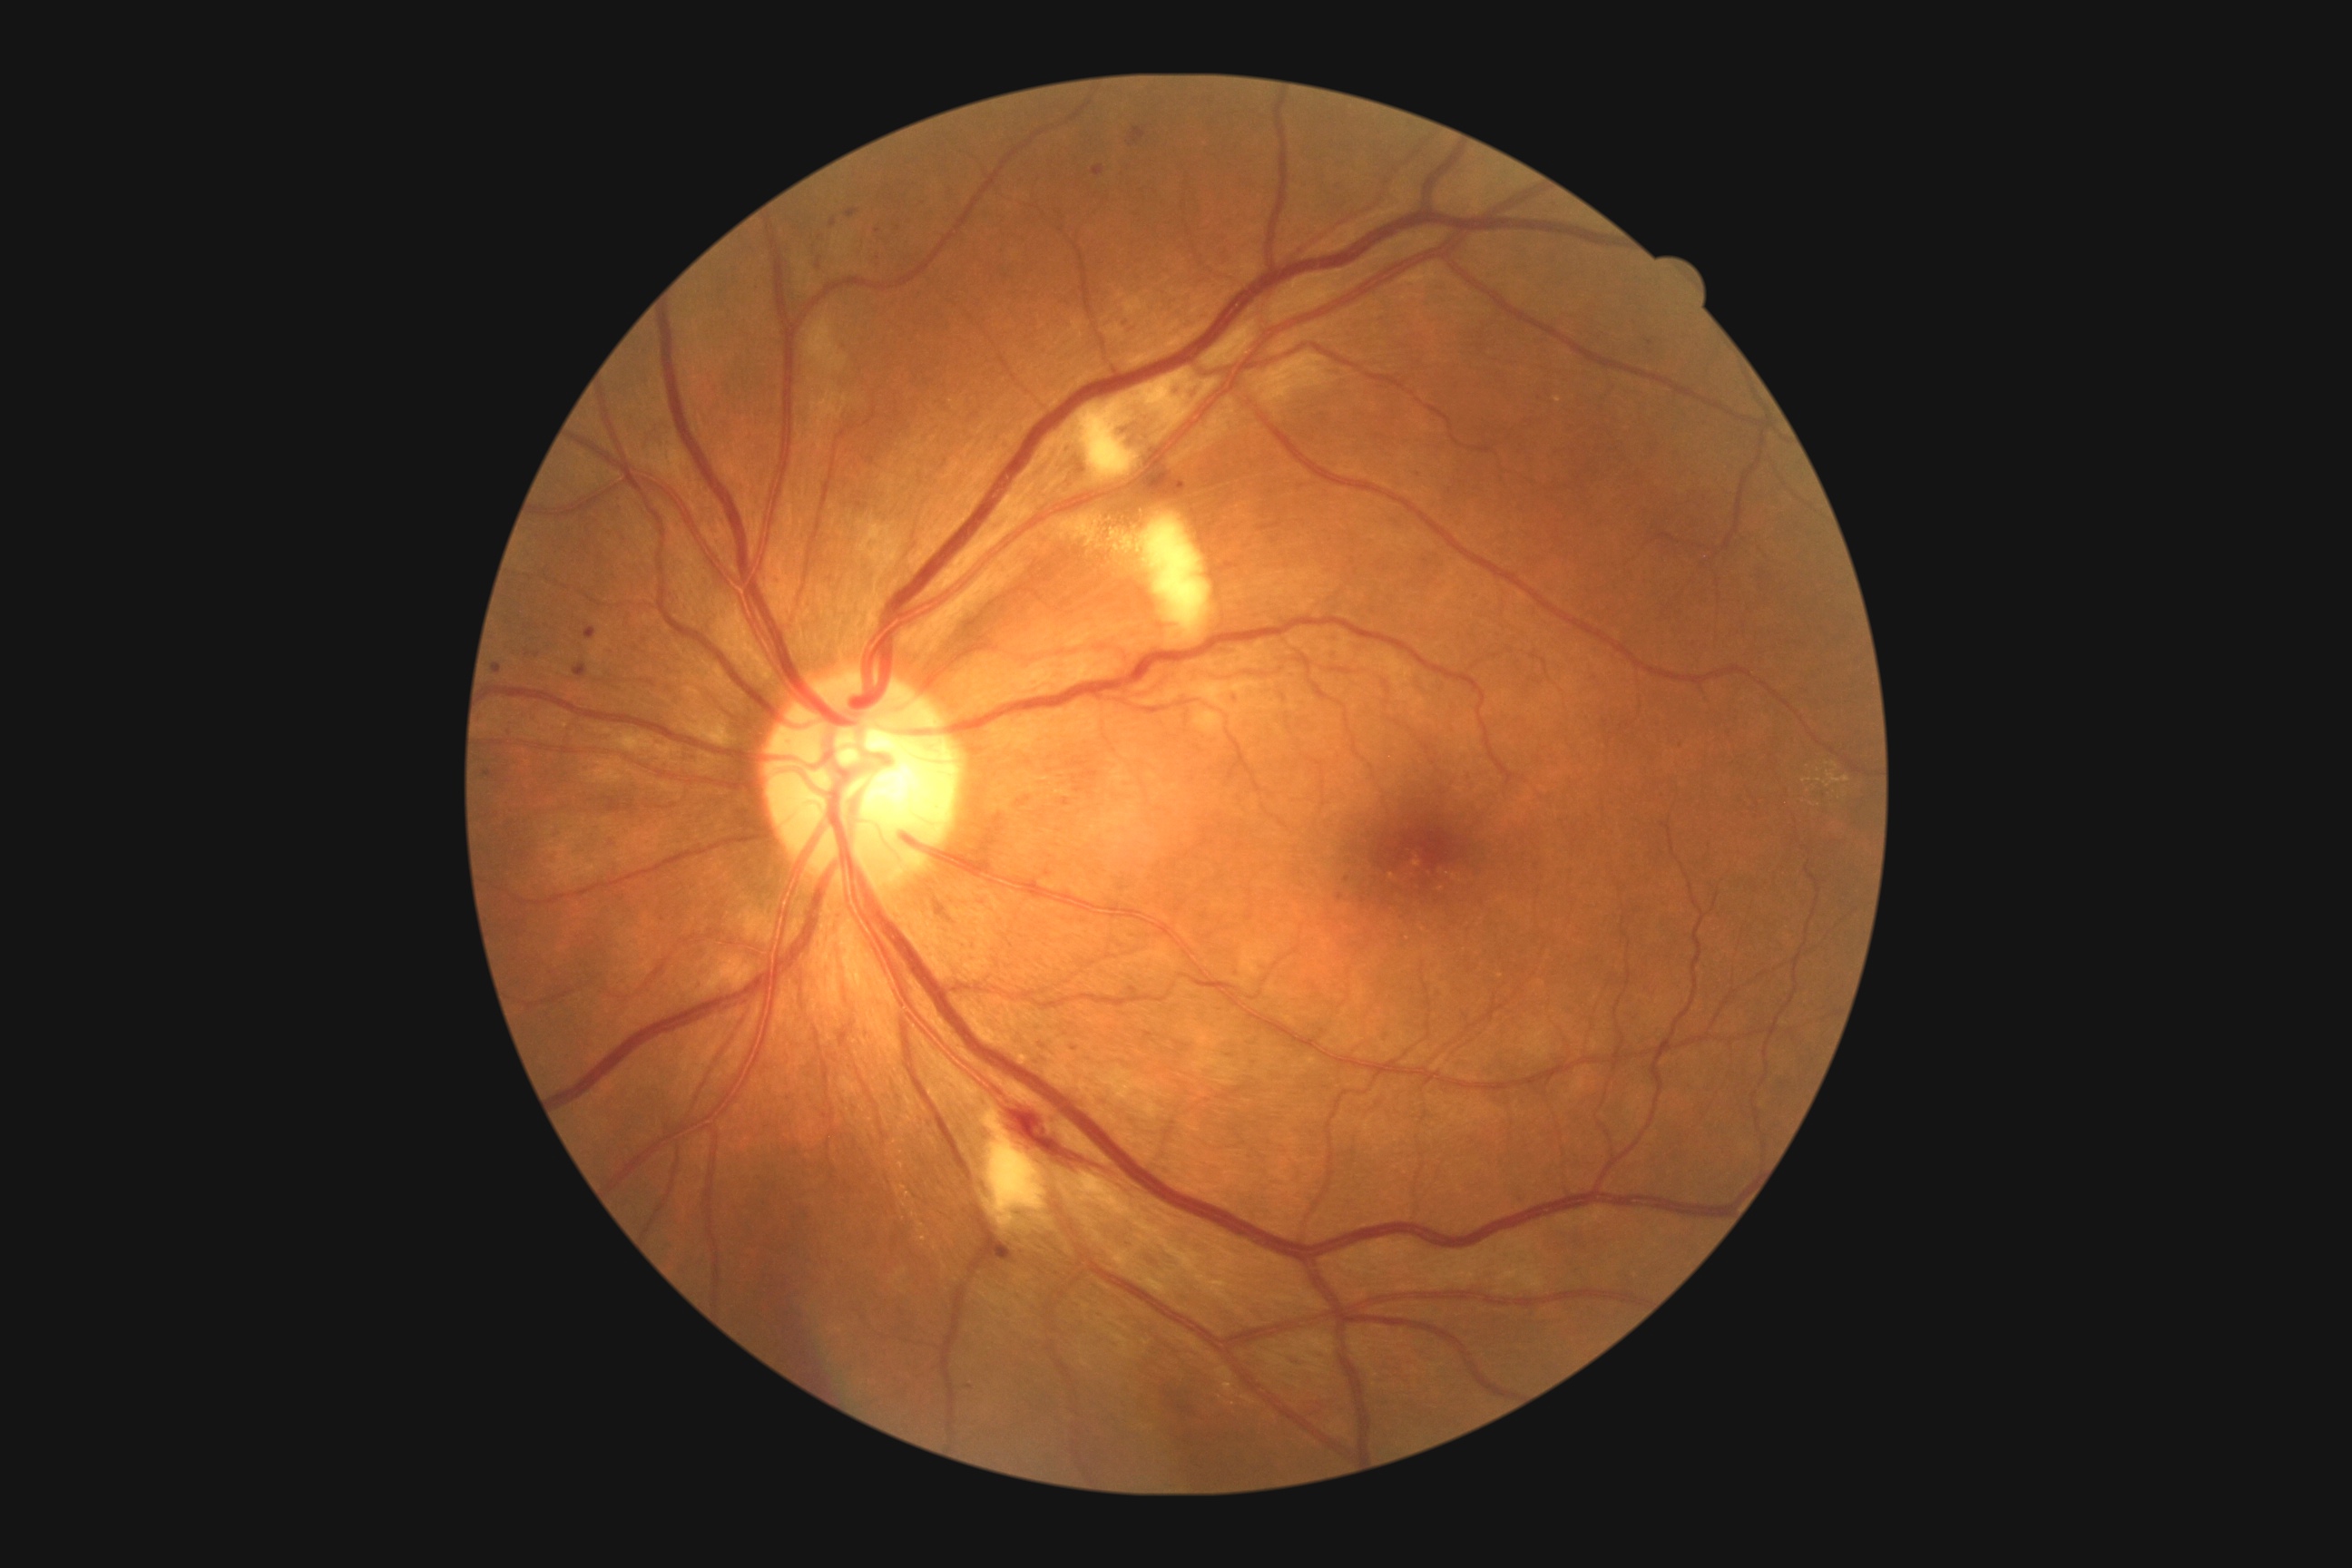

diabetic retinopathy (DR)@moderate NPDR (grade 2).